FOV: 45 degrees:
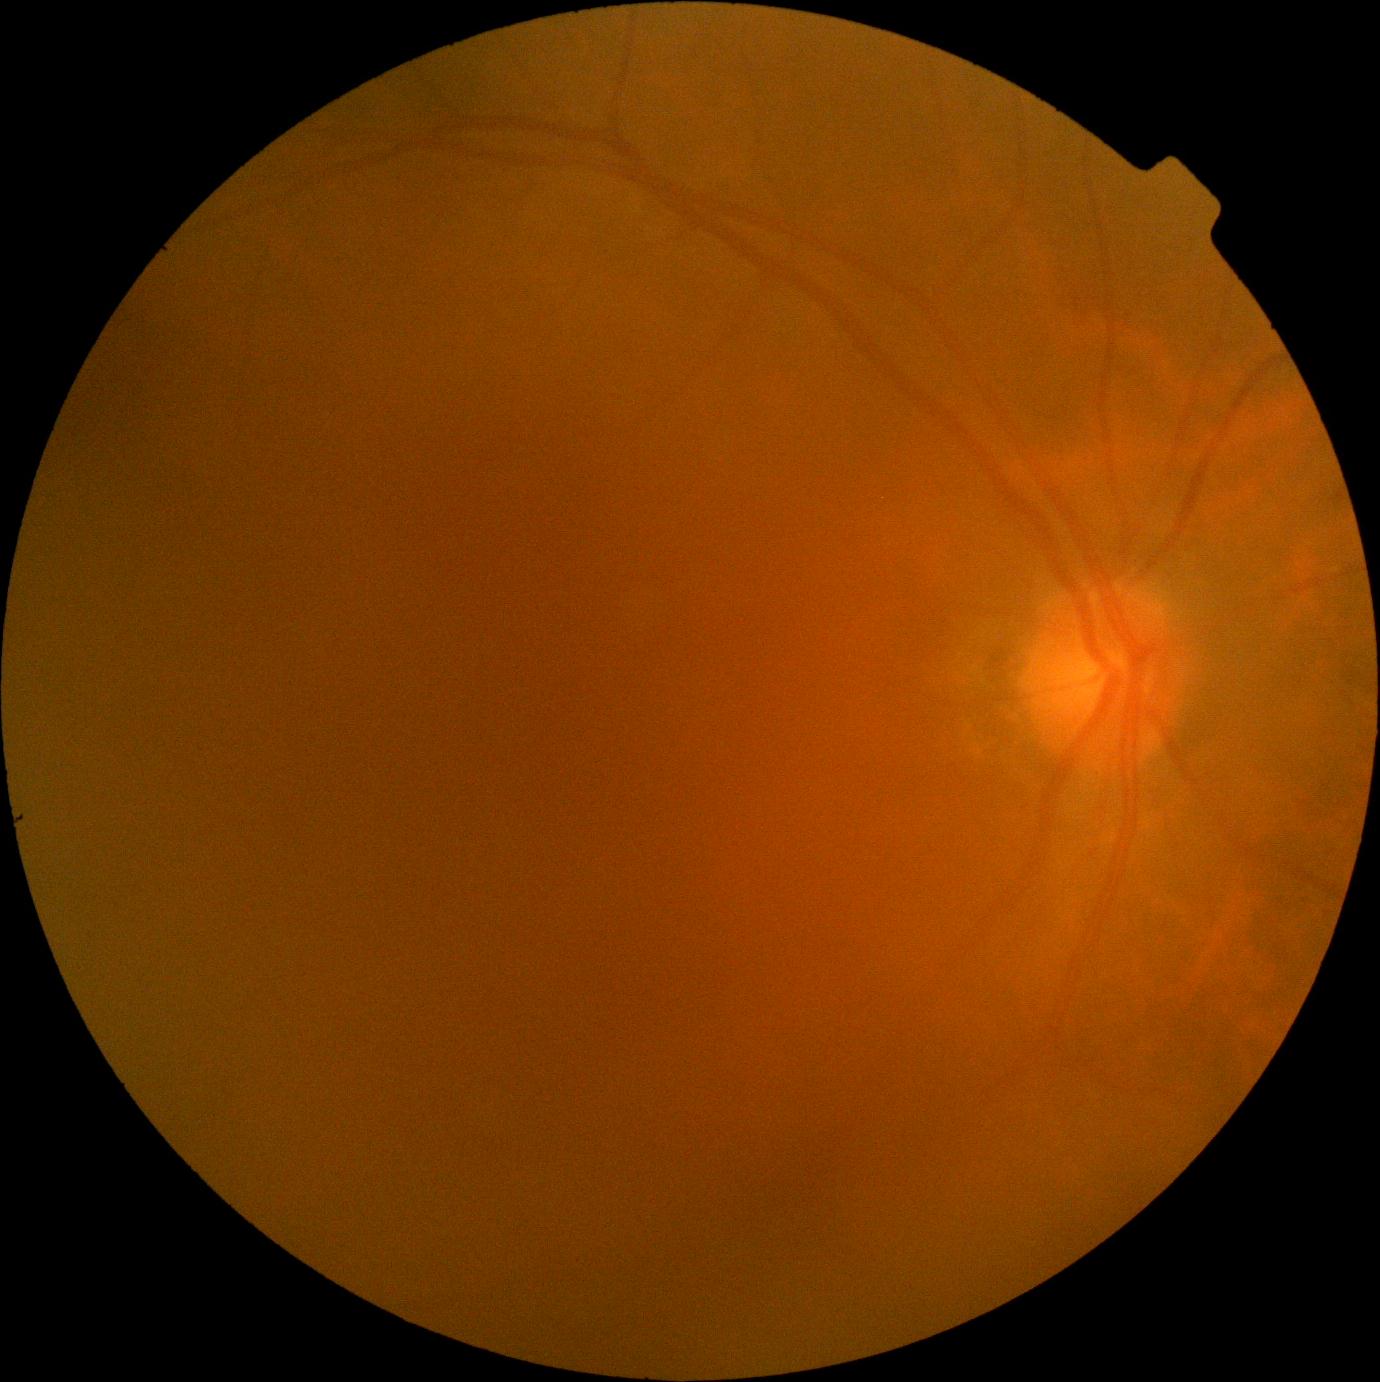

DR severity is no apparent diabetic retinopathy (grade 0). No diabetic retinal disease findings.